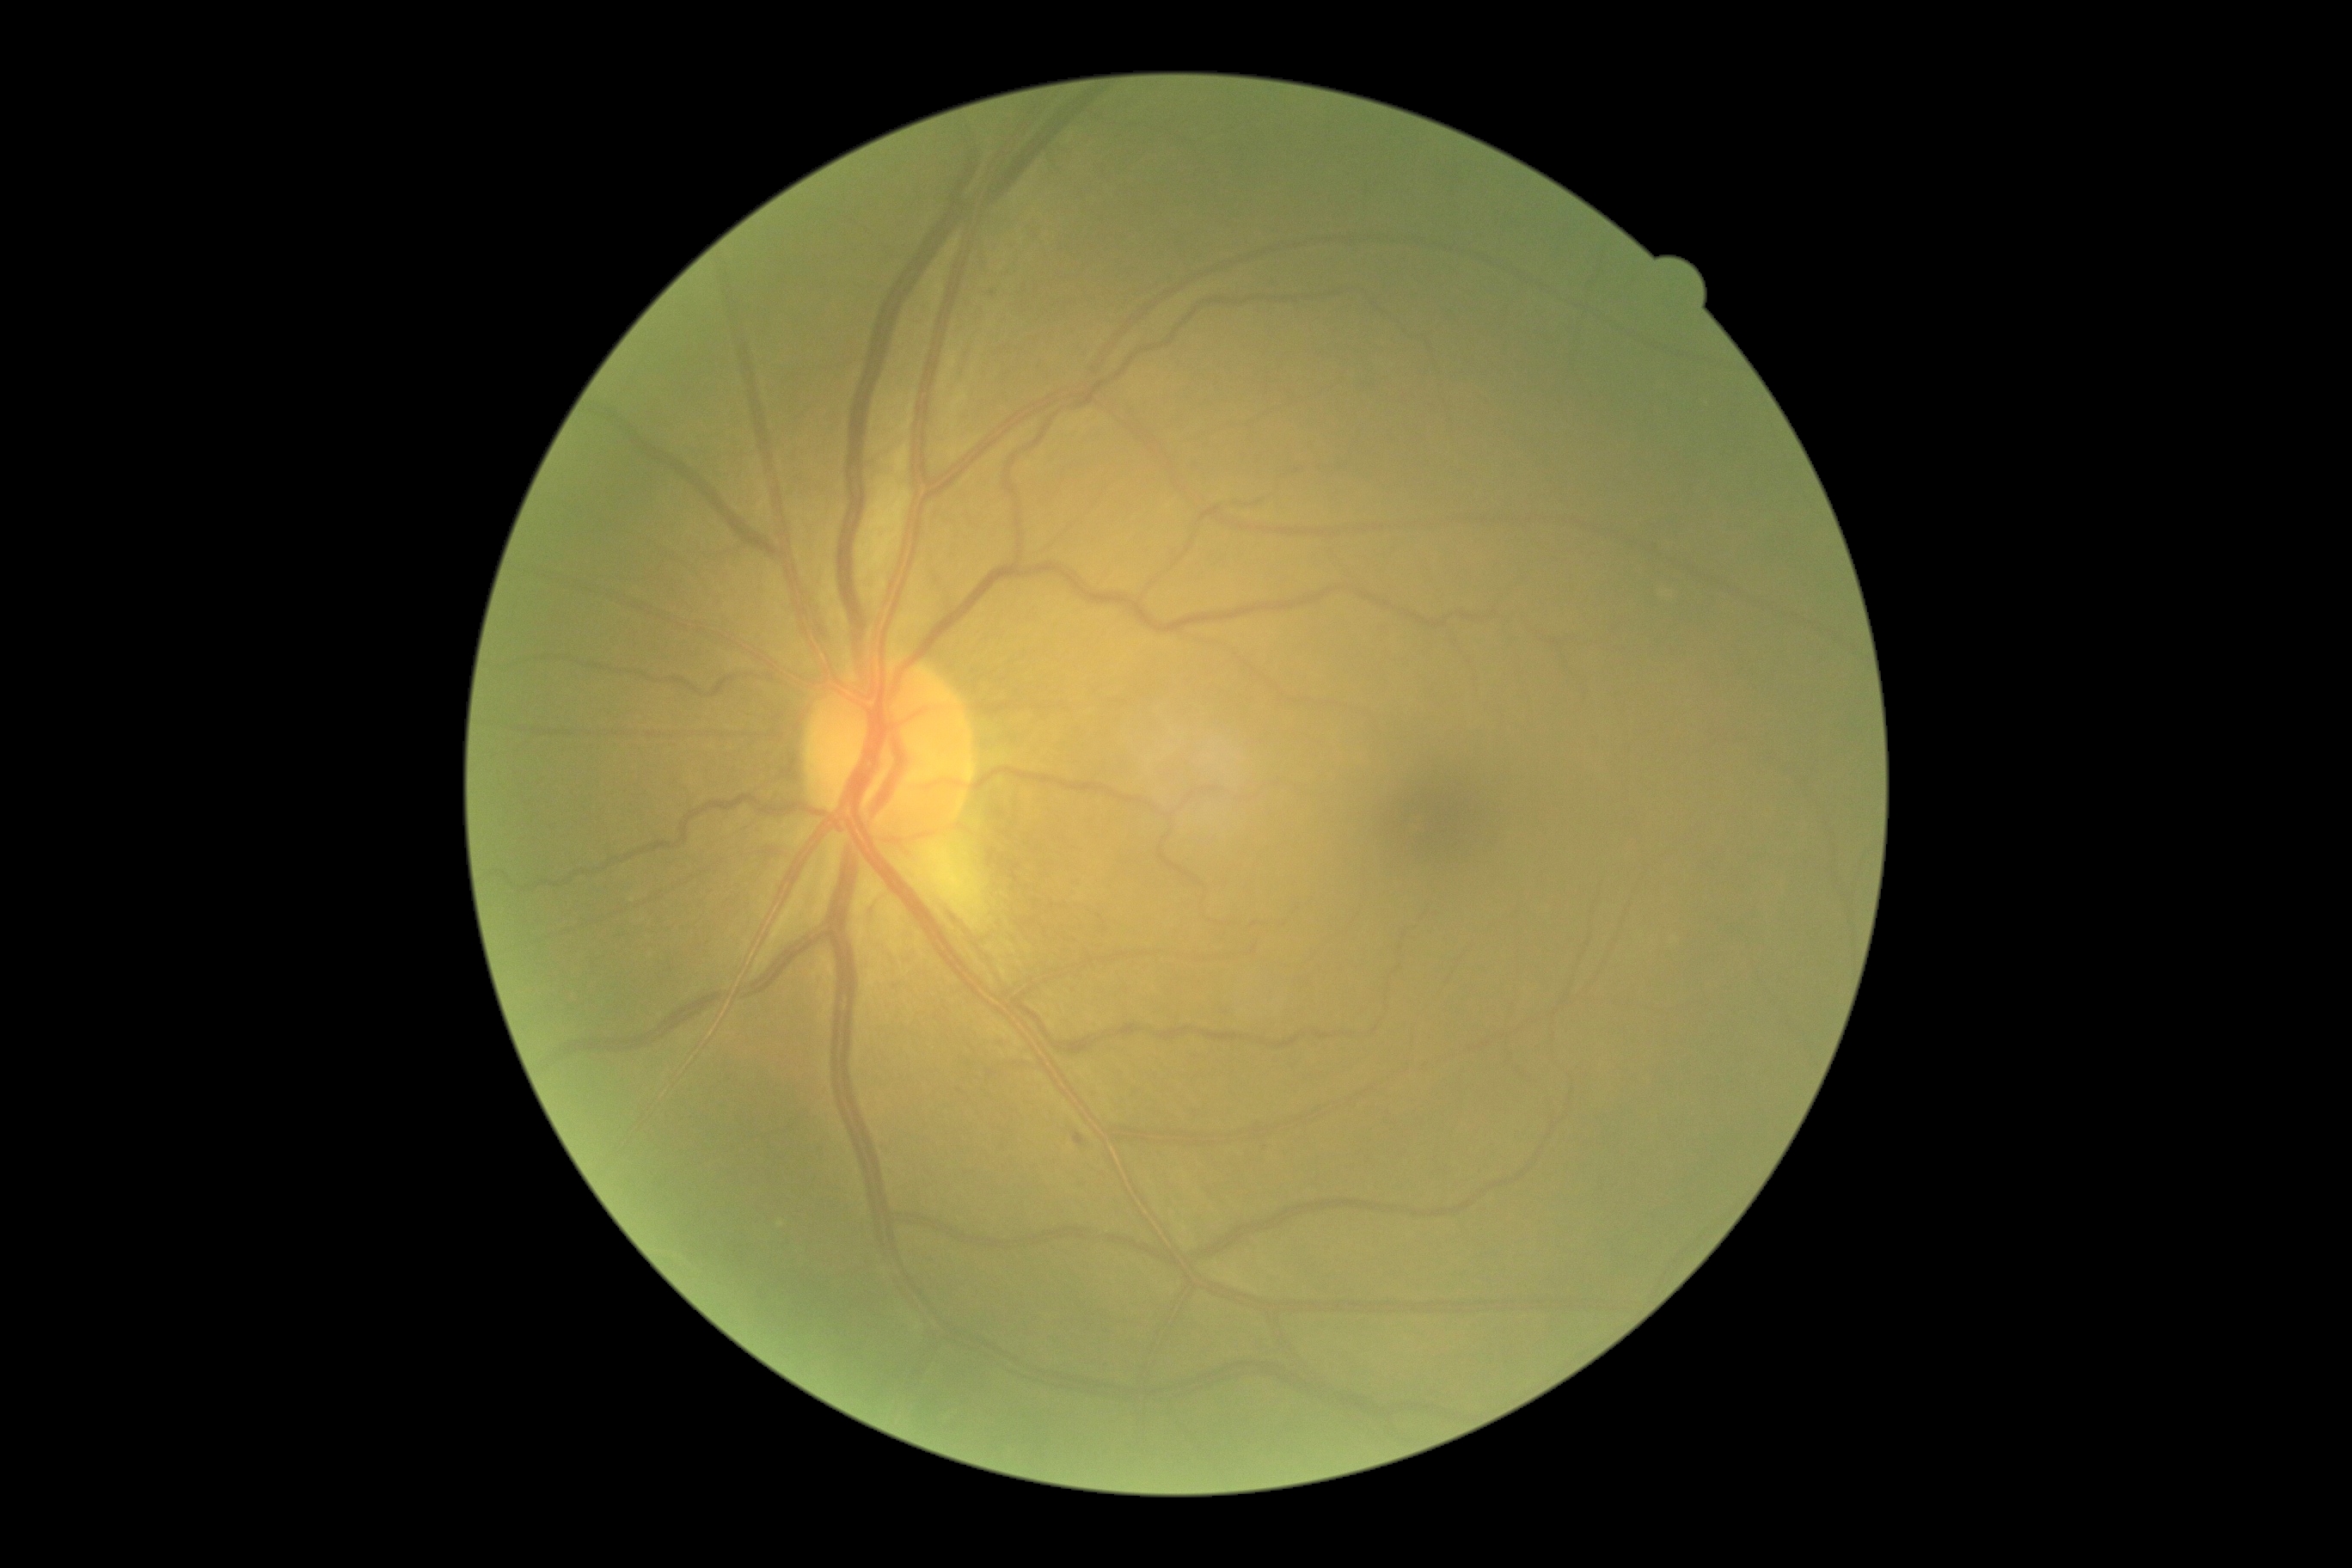

The retinopathy is classified as non-proliferative diabetic retinopathy. Retinopathy: 1.